FOV: 45 degrees; image size 2352x1568
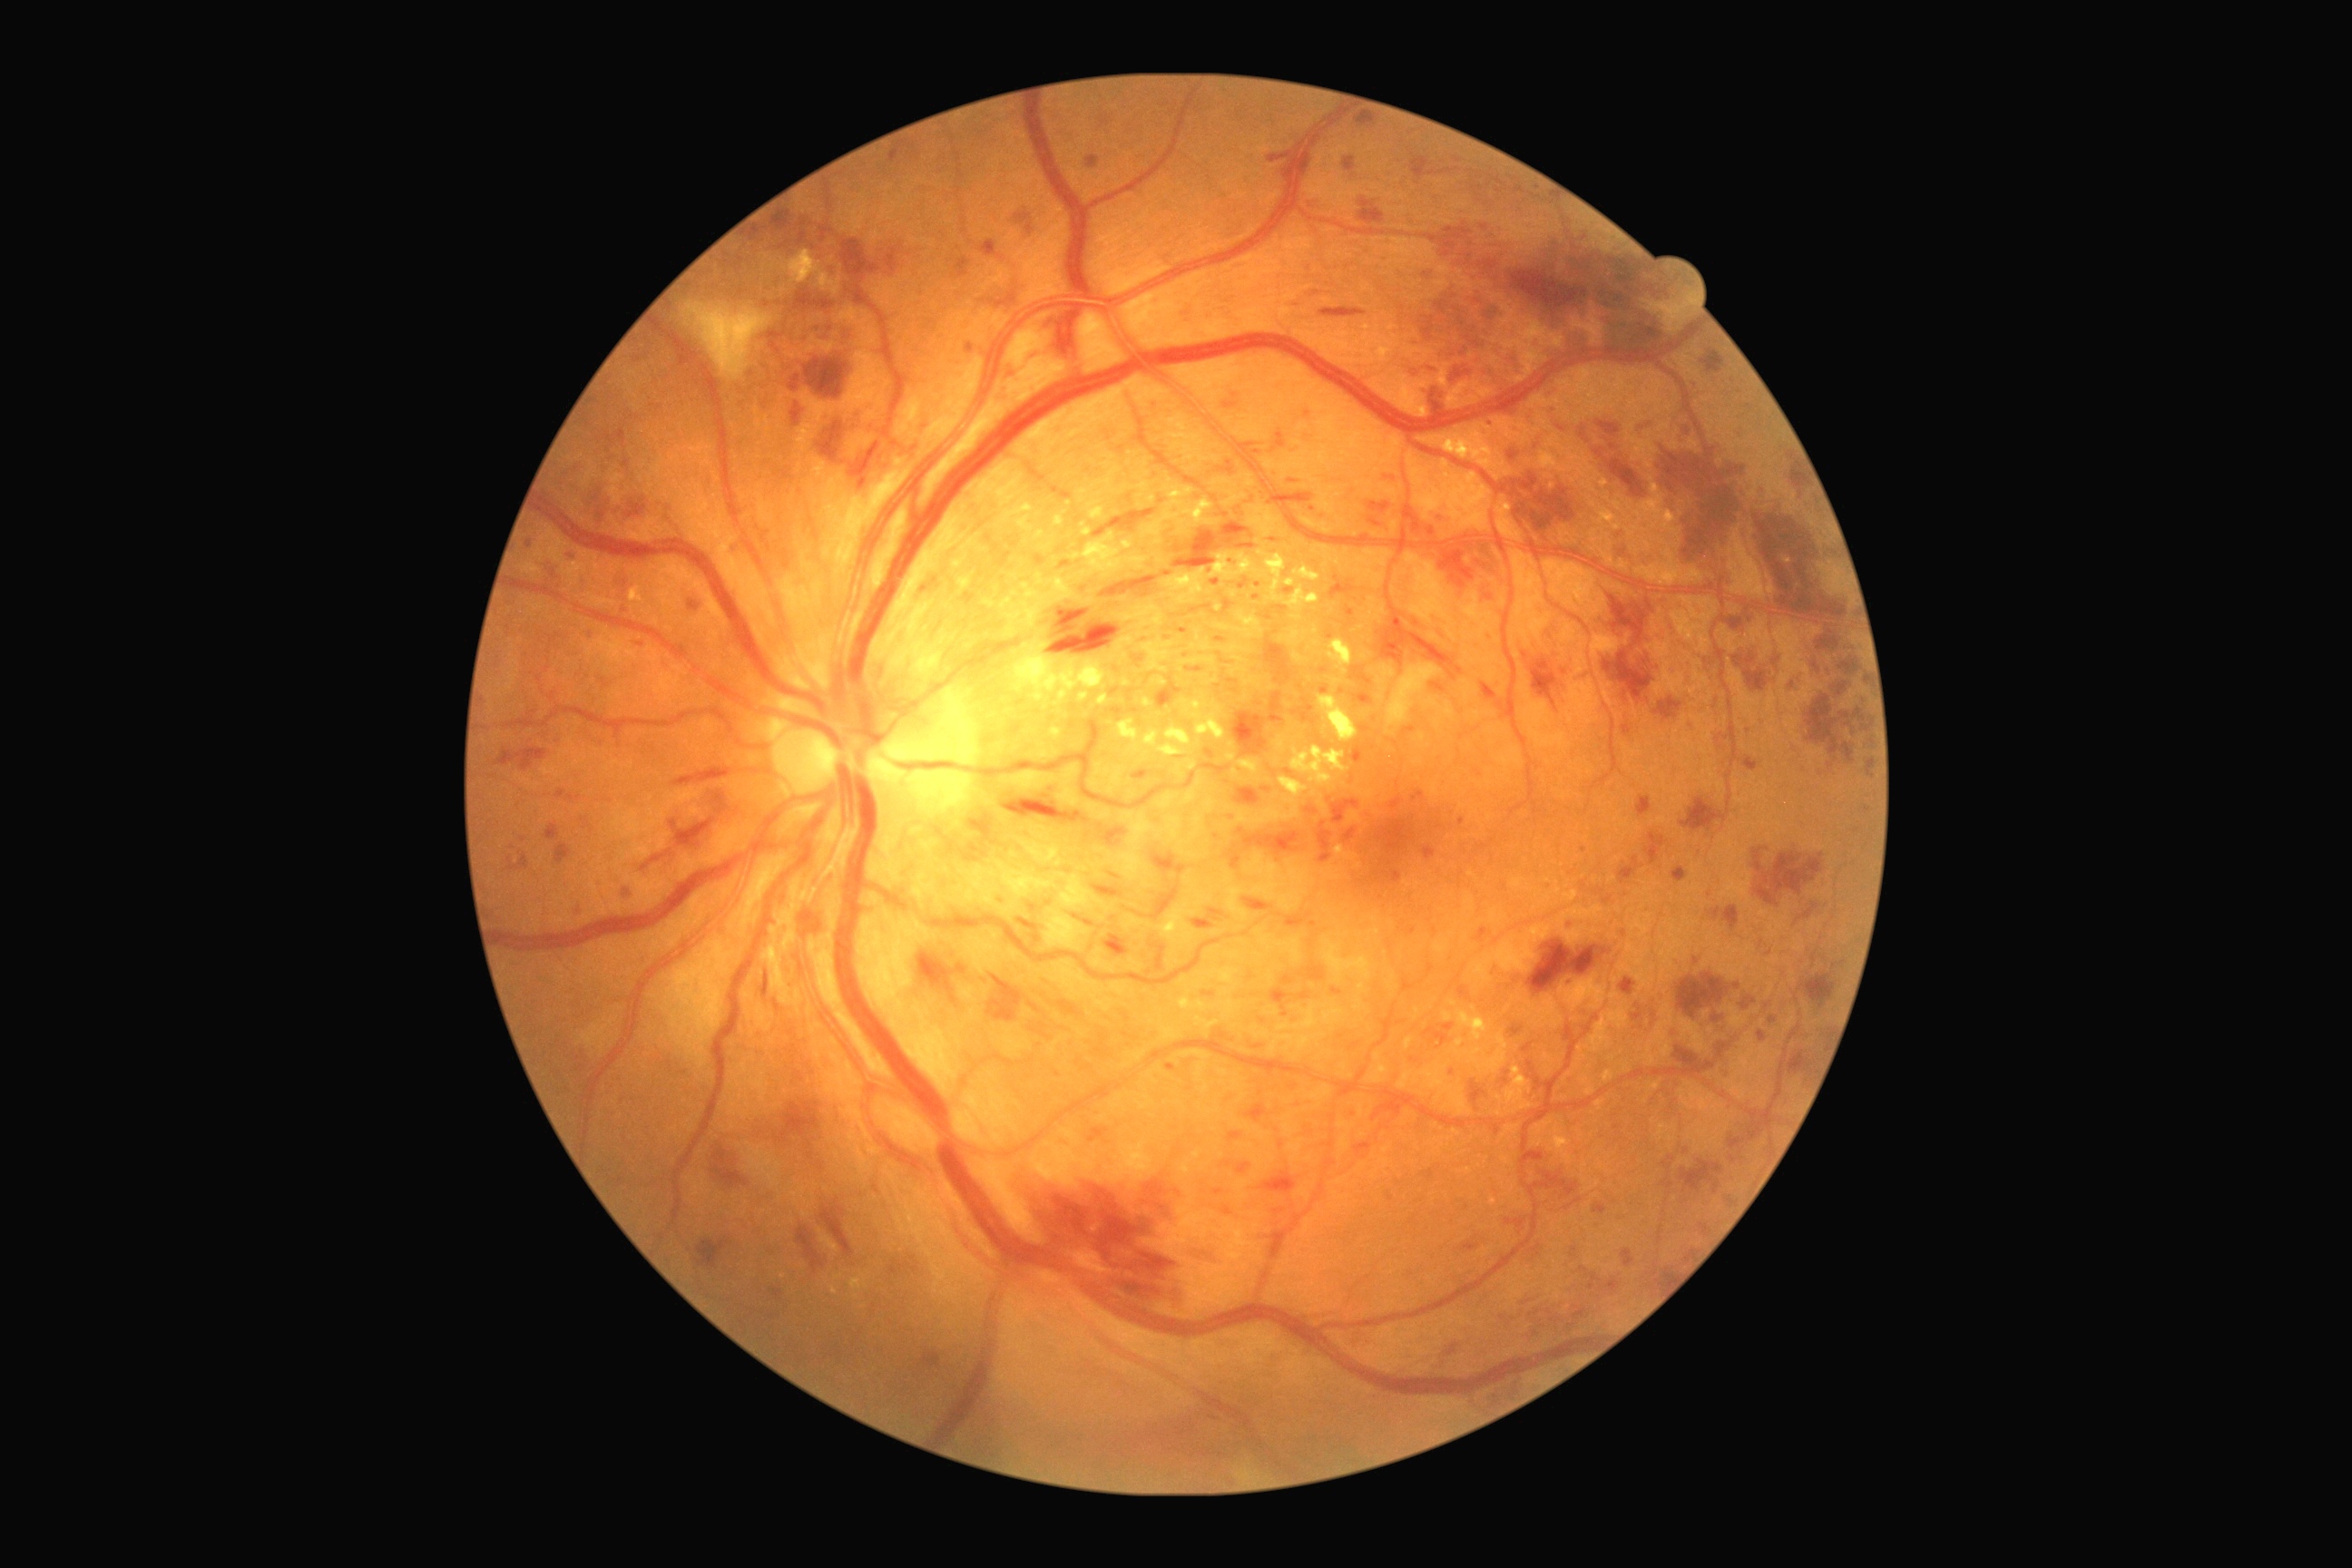 Retinopathy grade: severe non-proliferative diabetic retinopathy (3)
A subset of detected lesions:
microaneurysms (more not shown) = [1188, 667, 1202, 672] | [1545, 883, 1553, 890] | [1389, 798, 1404, 810] | [1384, 870, 1402, 885] | [1059, 562, 1072, 571] | [798, 231, 808, 244] | [979, 240, 1003, 260] | [1110, 687, 1121, 696] | [923, 1351, 941, 1369] | [573, 908, 582, 916] | [556, 790, 565, 799] | [1344, 828, 1358, 843] | [1769, 1017, 1778, 1024]
Small microaneurysms approximately at [1584,851] | [1696,962] | [553,575] | [530,545] | [1000,899] | [1461,822]
hemorrhages (more not shown) = [1529, 939, 1600, 995] | [1838, 681, 1847, 696] | [1850, 729, 1857, 740] | [1193, 1250, 1220, 1266] | [1471, 1081, 1485, 1104] | [495, 747, 547, 770] | [1645, 832, 1665, 867] | [1157, 678, 1182, 709] | [778, 1099, 827, 1148] | [1680, 798, 1727, 830] | [1620, 977, 1636, 995] | [749, 228, 765, 242] | [1411, 153, 1431, 181] | [674, 769, 732, 787] | [1654, 438, 1750, 585] | [1732, 643, 1769, 692] | [1093, 885, 1124, 897]
Small hemorrhages approximately at [669,853] | [1830,632]
hard exudates (more not shown) = [1553, 1128, 1573, 1164] | [1159, 903, 1197, 945] | [1231, 770, 1240, 779] | [1200, 640, 1211, 651] | [1122, 680, 1132, 687] | [1141, 638, 1175, 672] | [1144, 478, 1215, 545] | [1493, 473, 1500, 482] | [1504, 469, 1514, 478] | [1293, 565, 1320, 582] | [1152, 678, 1168, 687] | [631, 585, 645, 603] | [1070, 531, 1150, 580]
Small hard exudates approximately at [1458,1052] | [1258,542] | [1473,1009] | [1084,492]